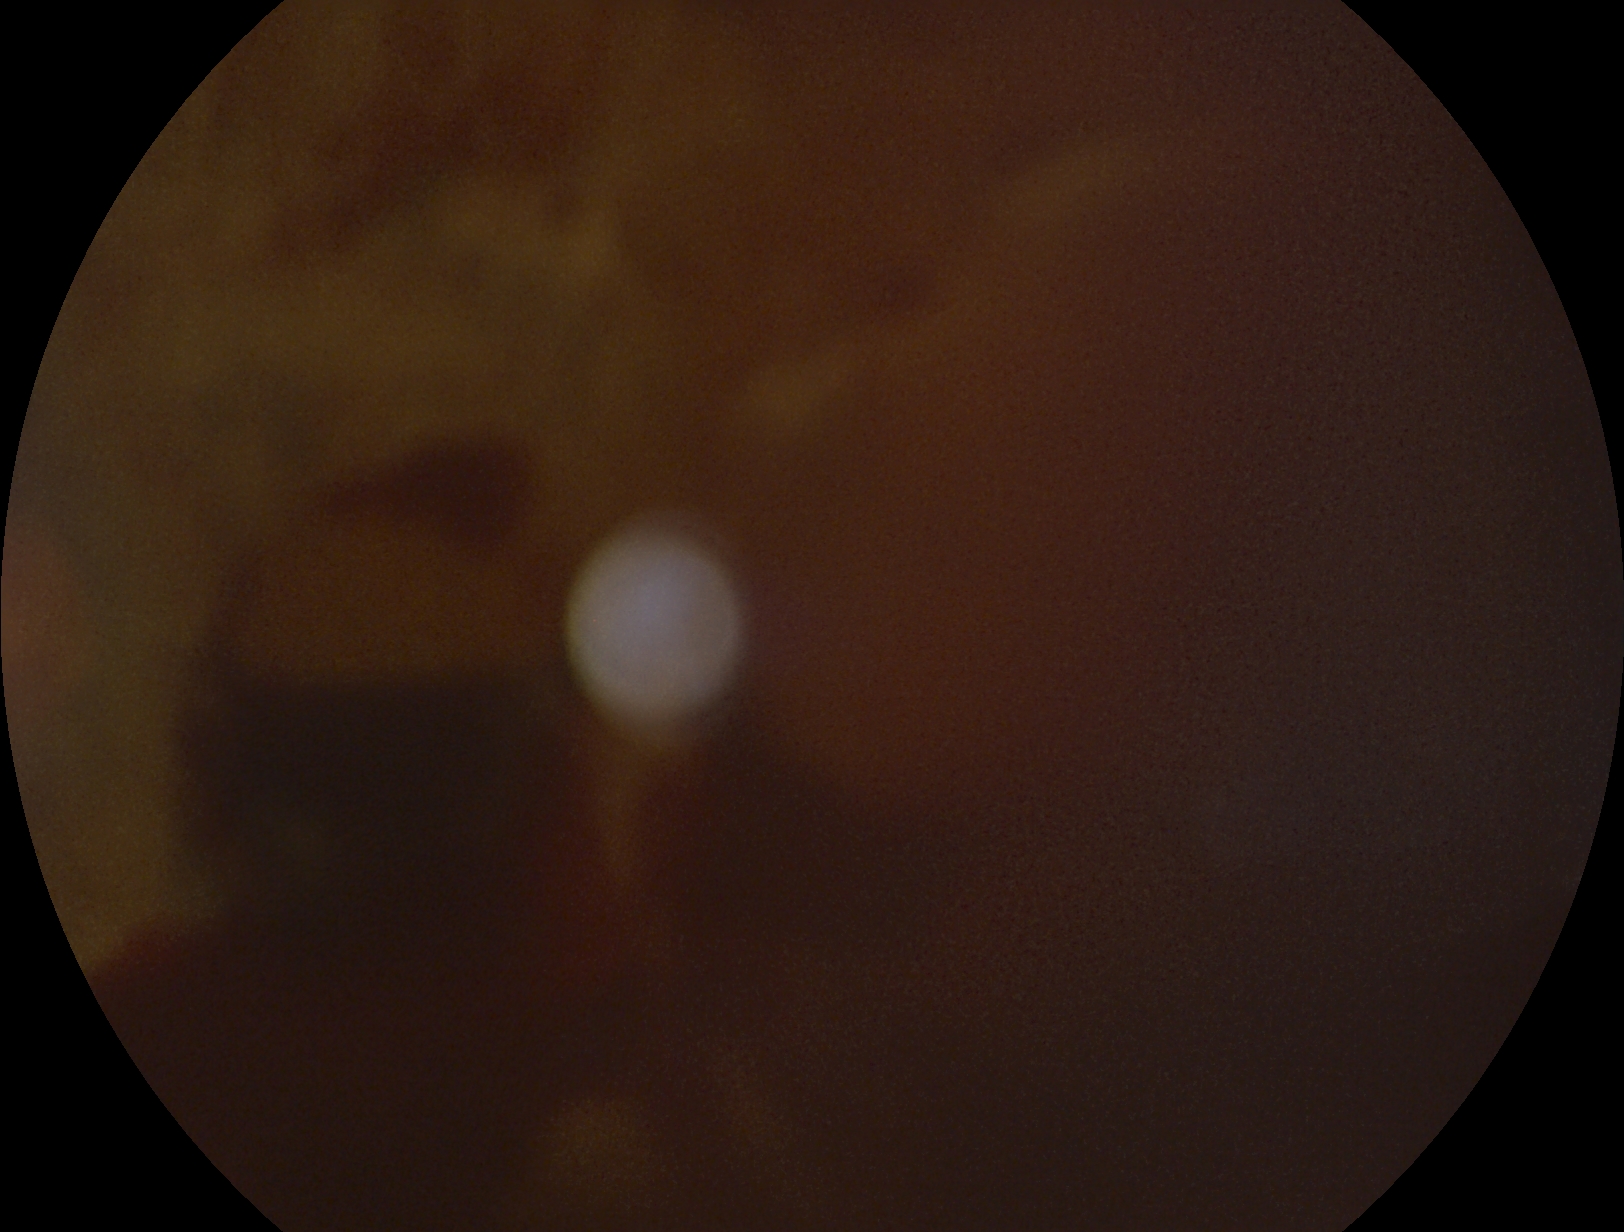
Retinopathy: PDR (grade 4).